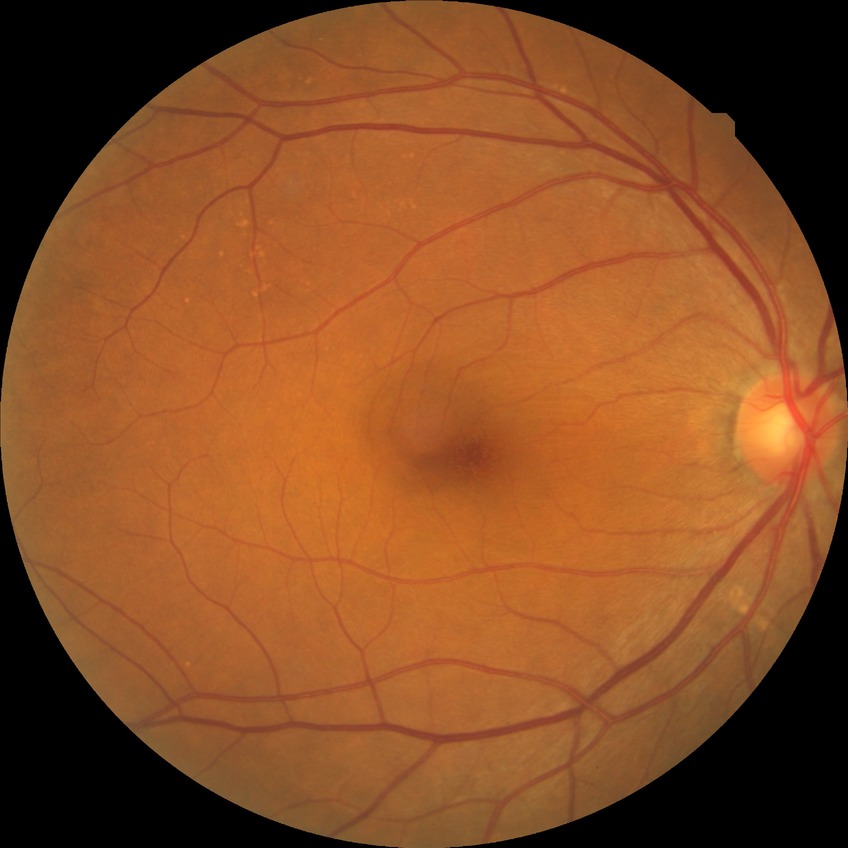
{
  "davis_grade": "no diabetic retinopathy"
}